No pharmacologic dilation · NIDEK AFC-230 · 848x848px · color fundus photograph: 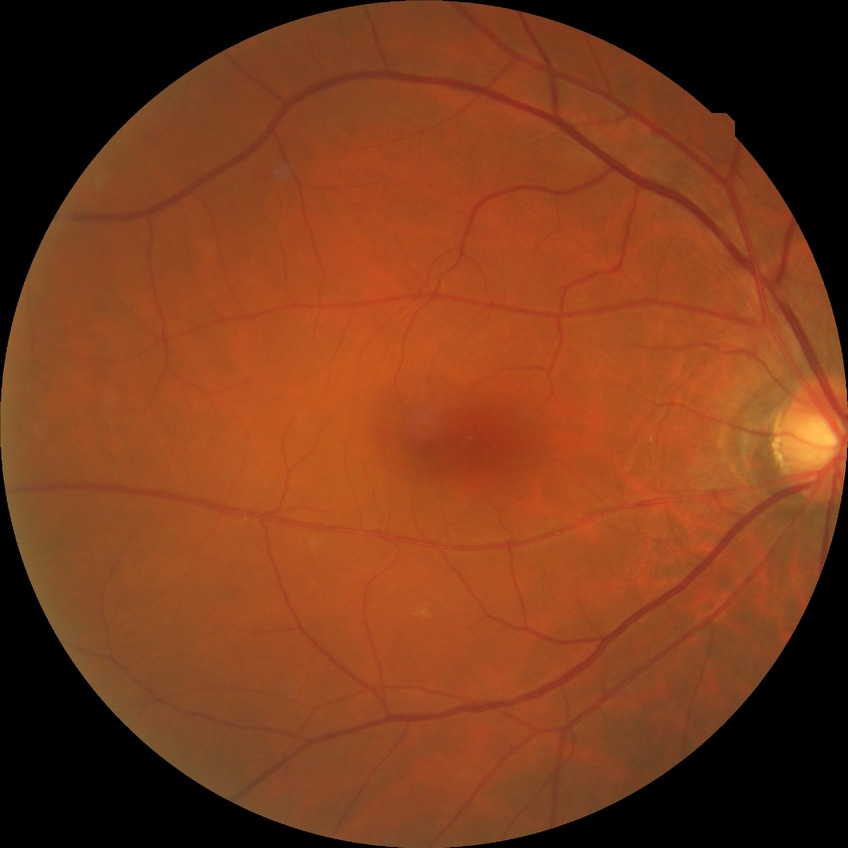

Diabetic retinopathy (DR): no diabetic retinopathy (NDR).